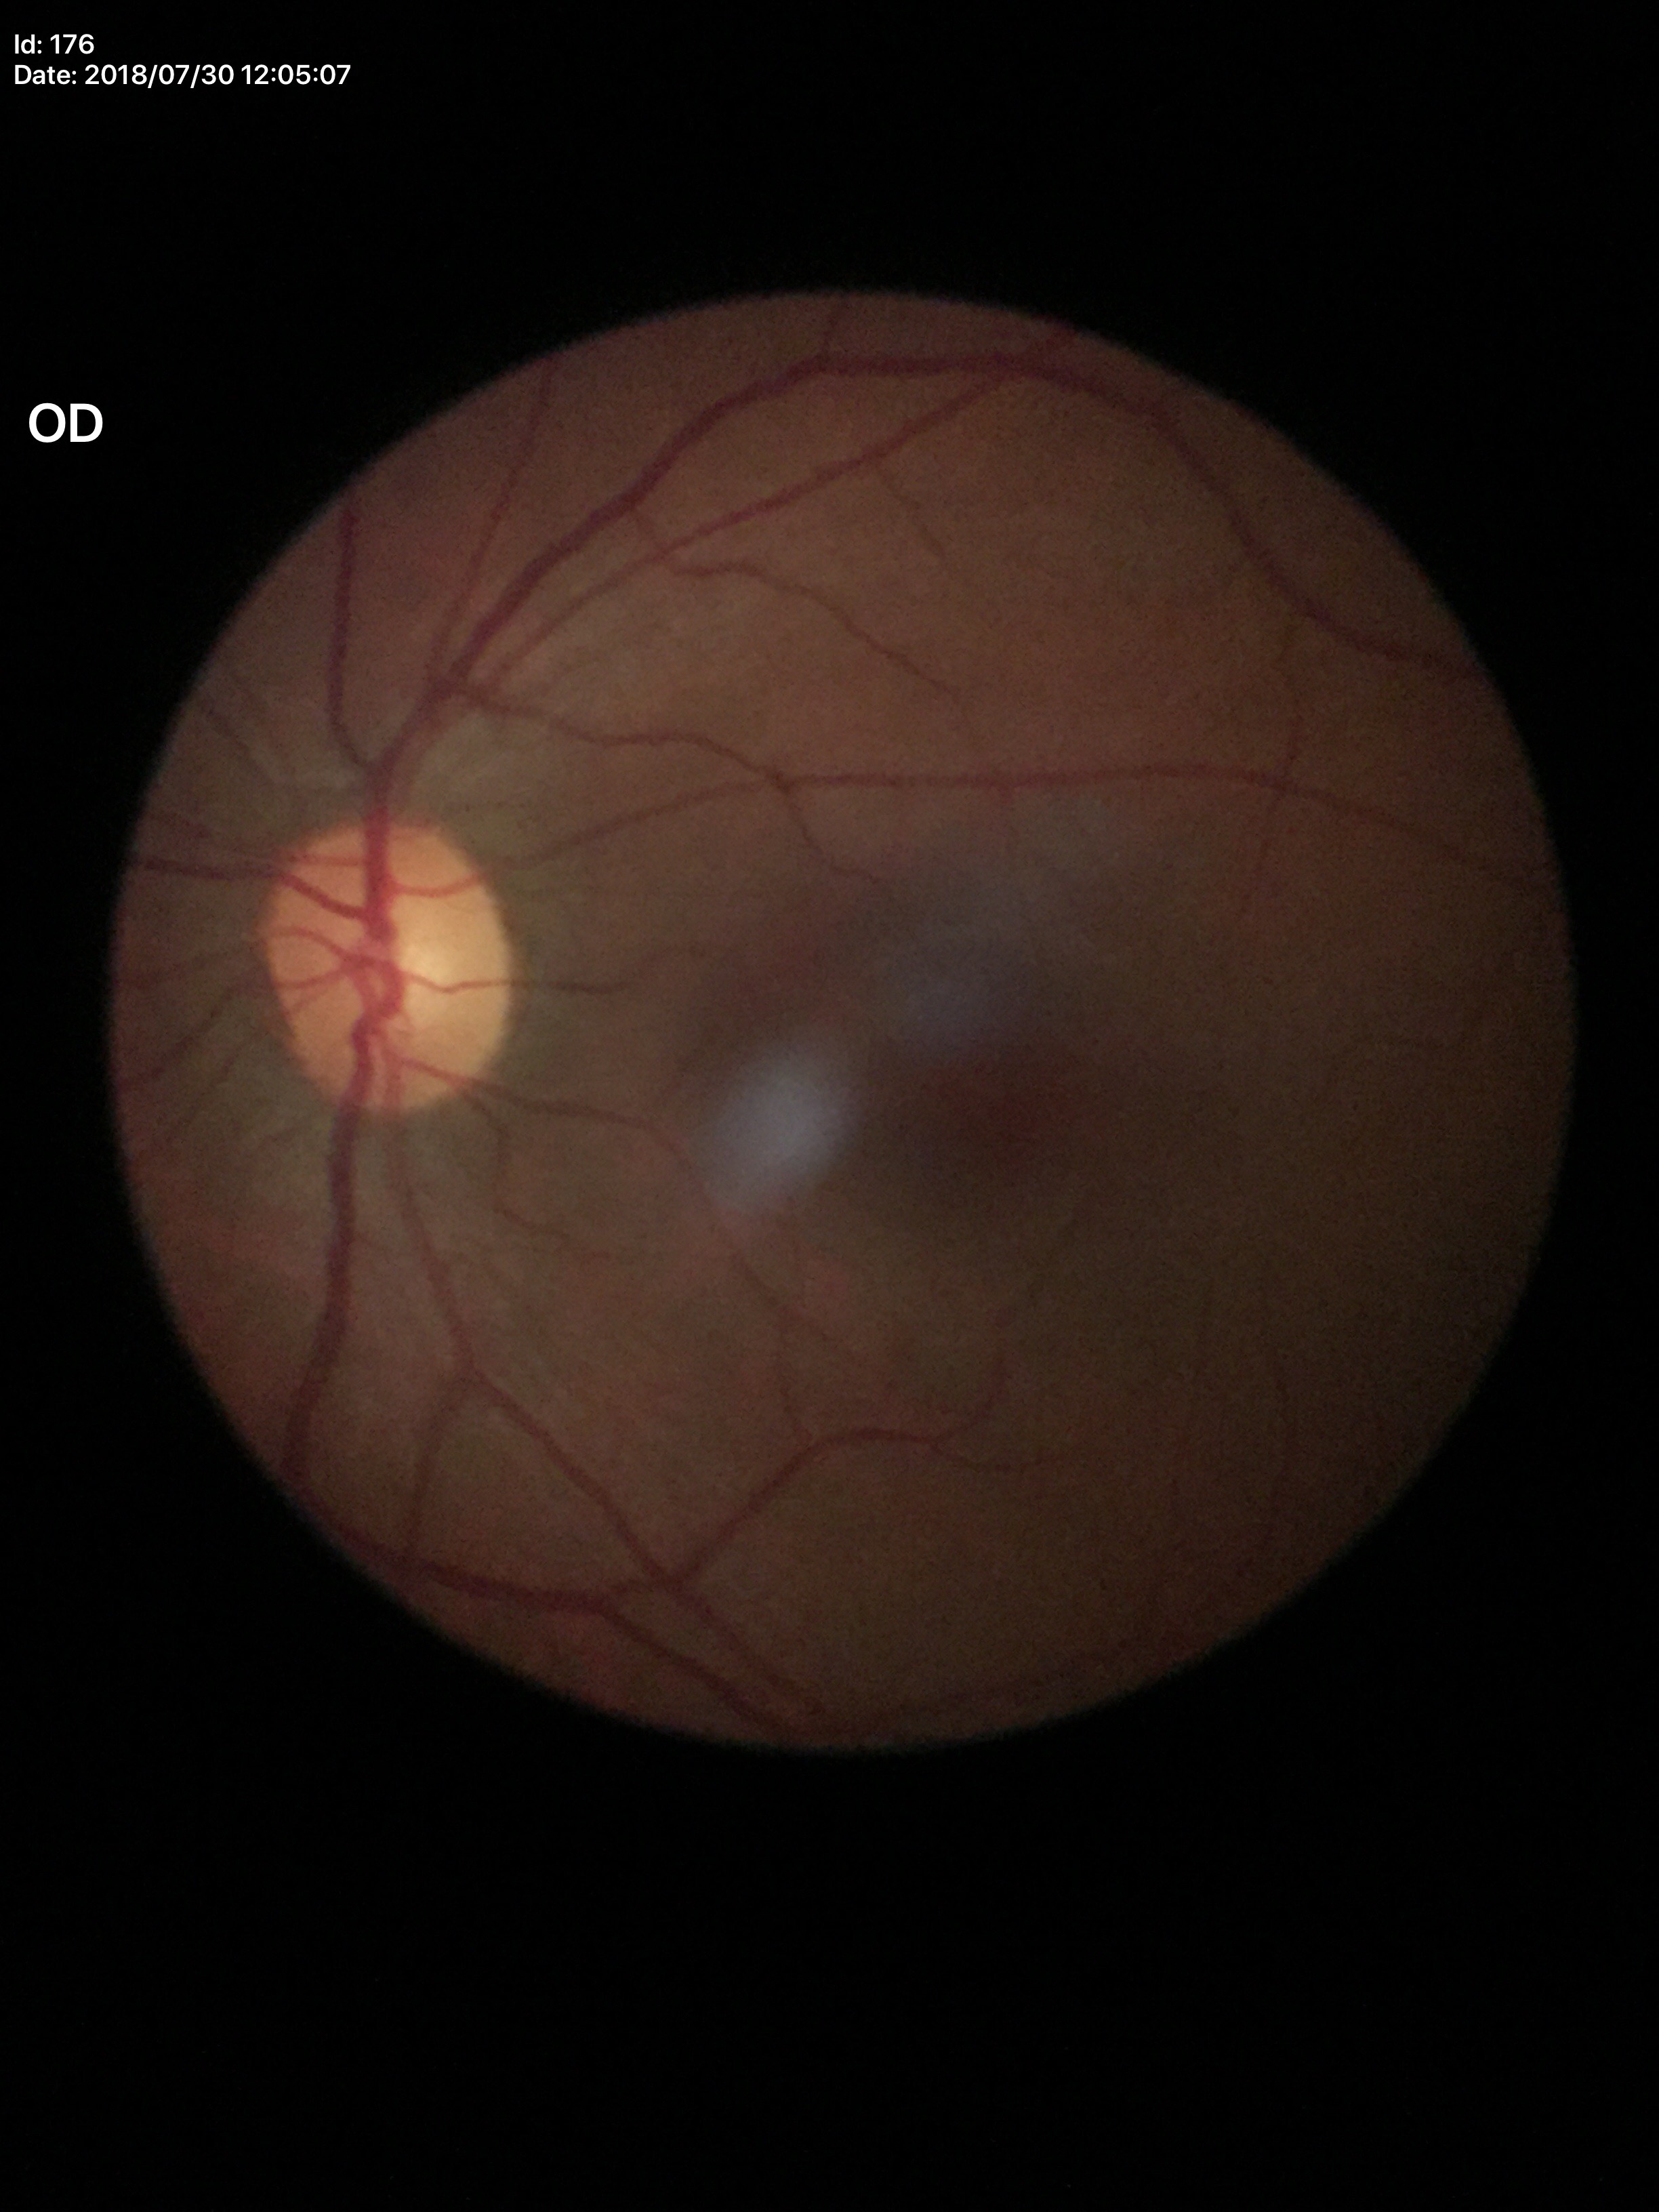 Glaucoma screening impression: not suspect. Vertical cup-disc ratio is 0.52.